2048 by 1536 pixels.
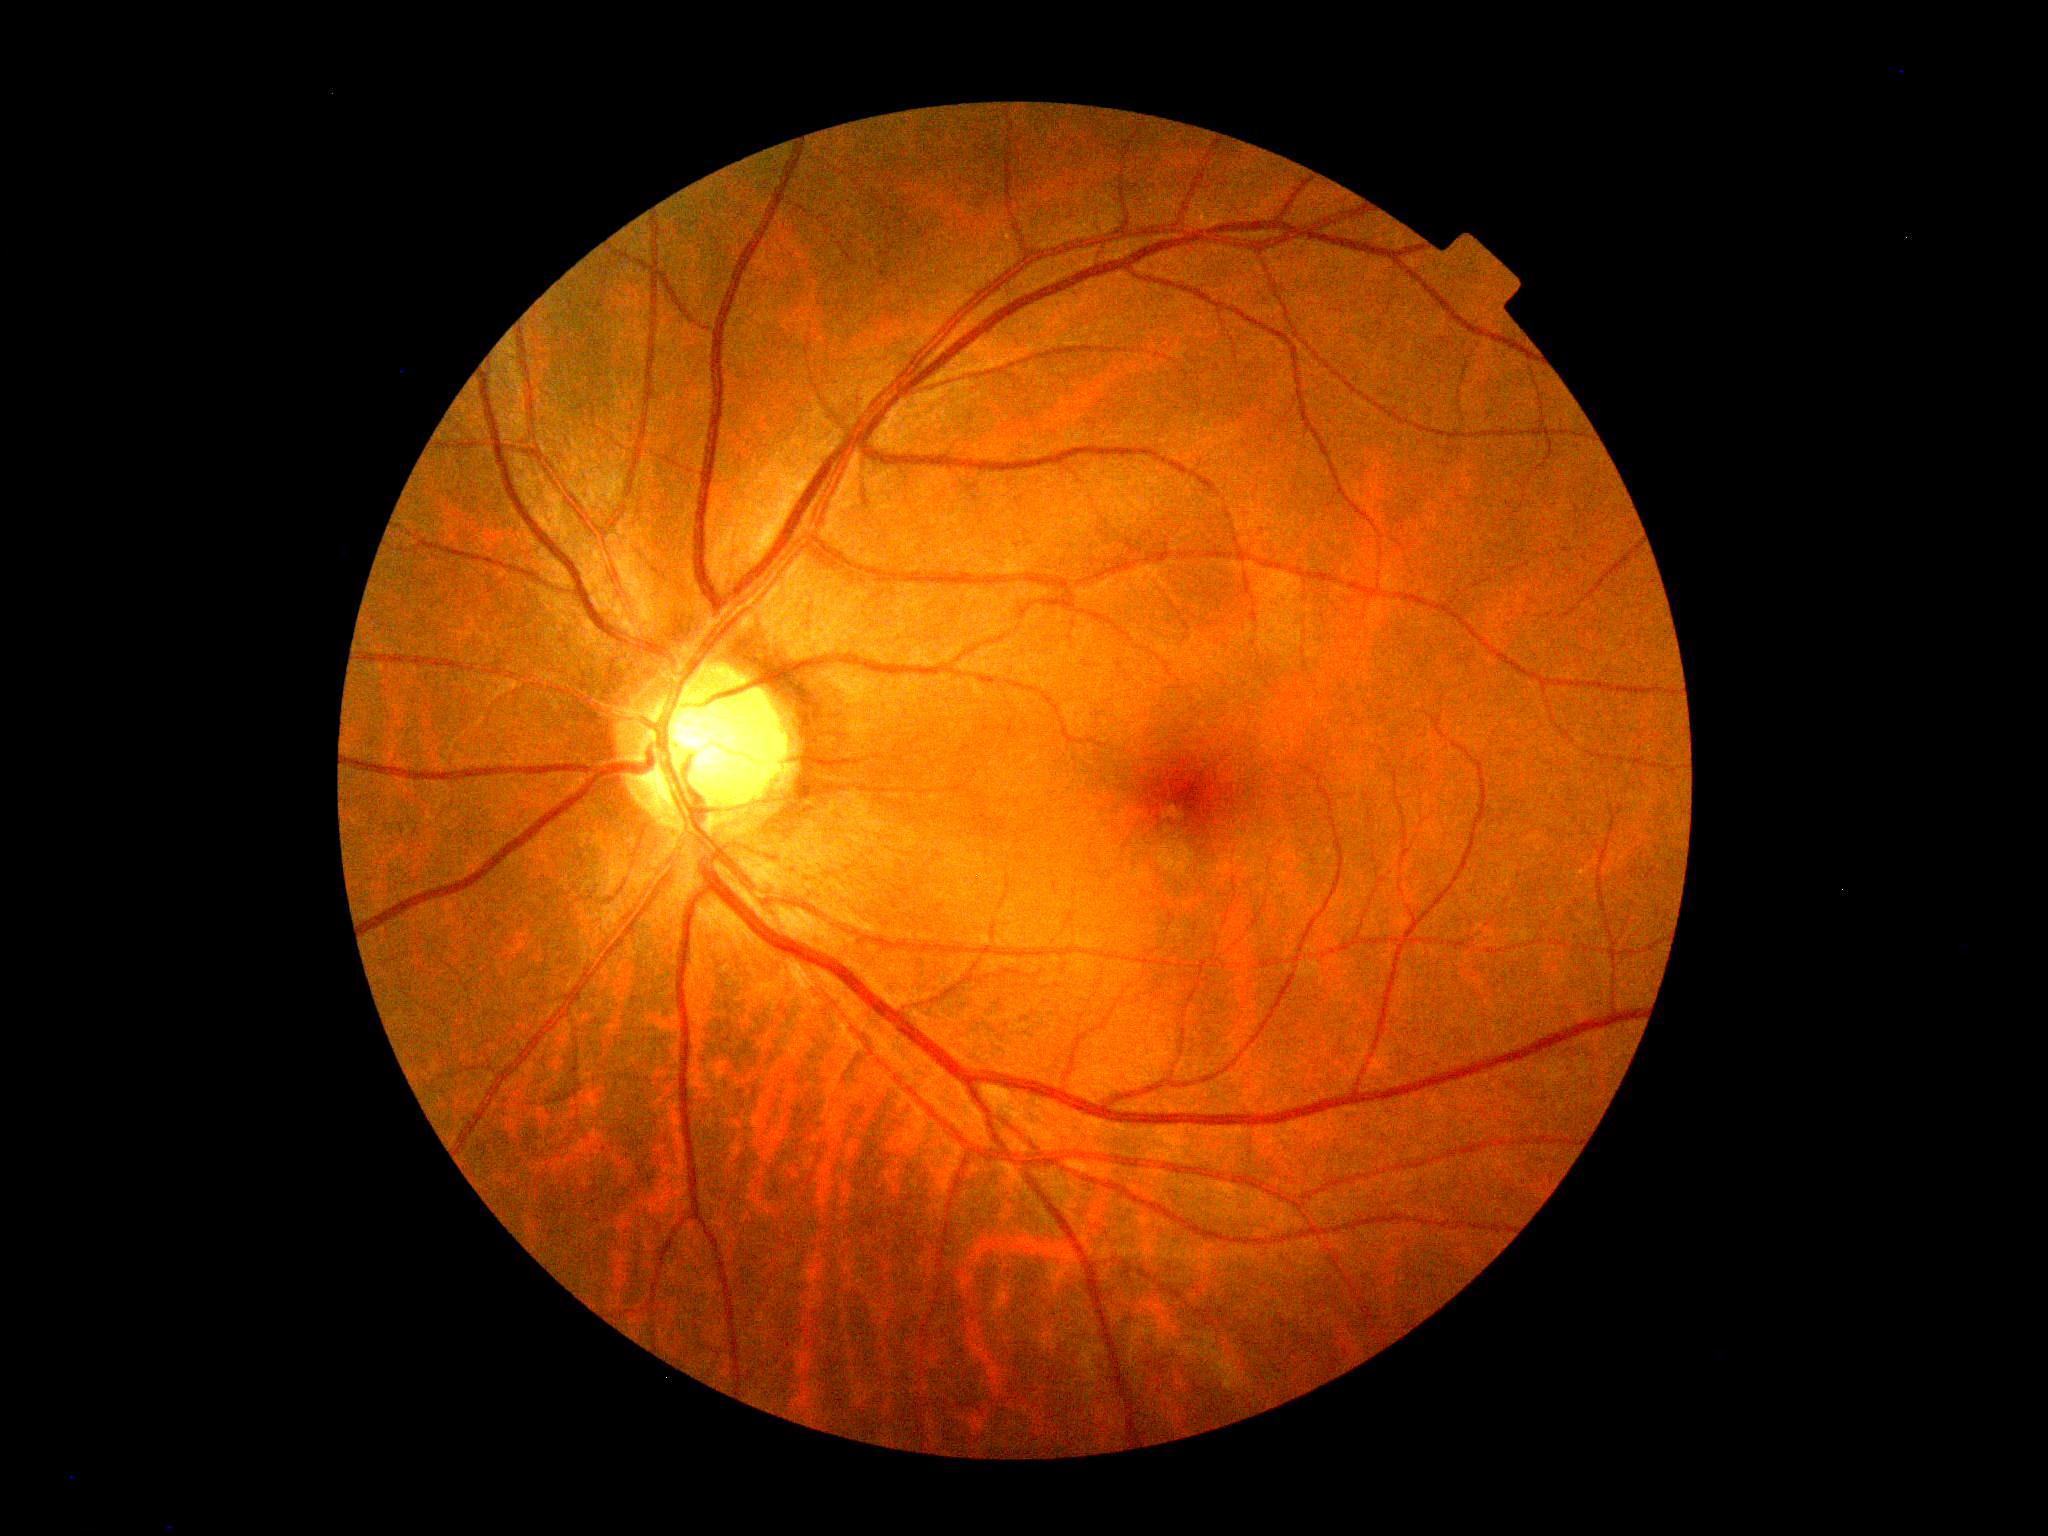 DR: grade 0 (no apparent retinopathy).